Camera: NIDEK AFC-230 · nonmydriatic fundus photograph · 848 x 848 pixels
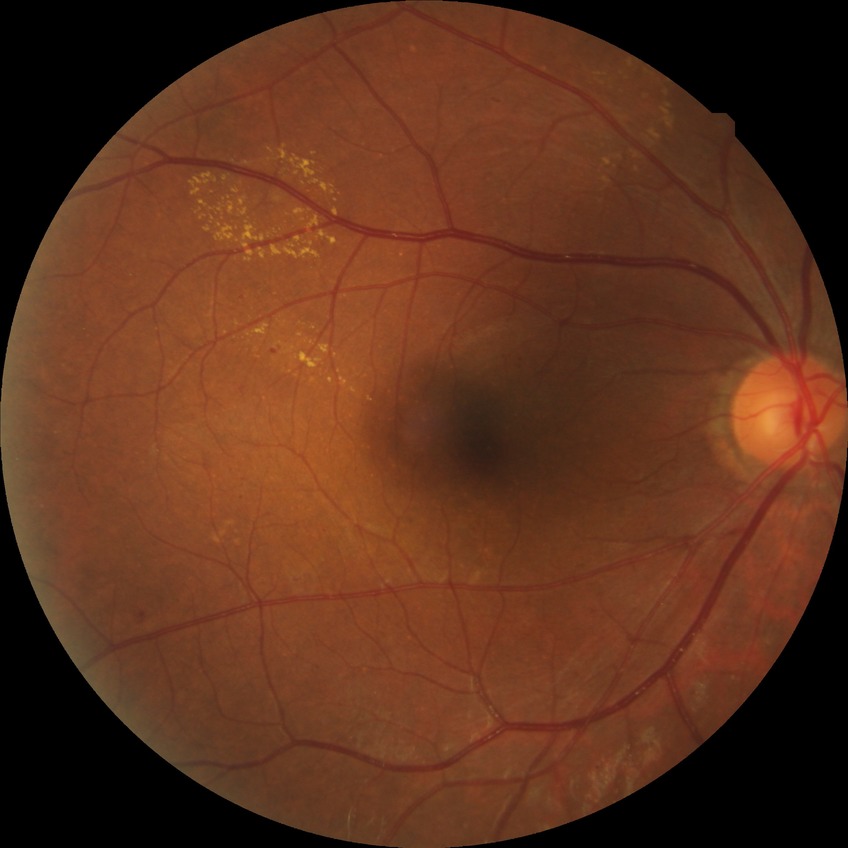

* diabetic retinopathy severity — pre-proliferative diabetic retinopathy
* DR class — non-proliferative diabetic retinopathy